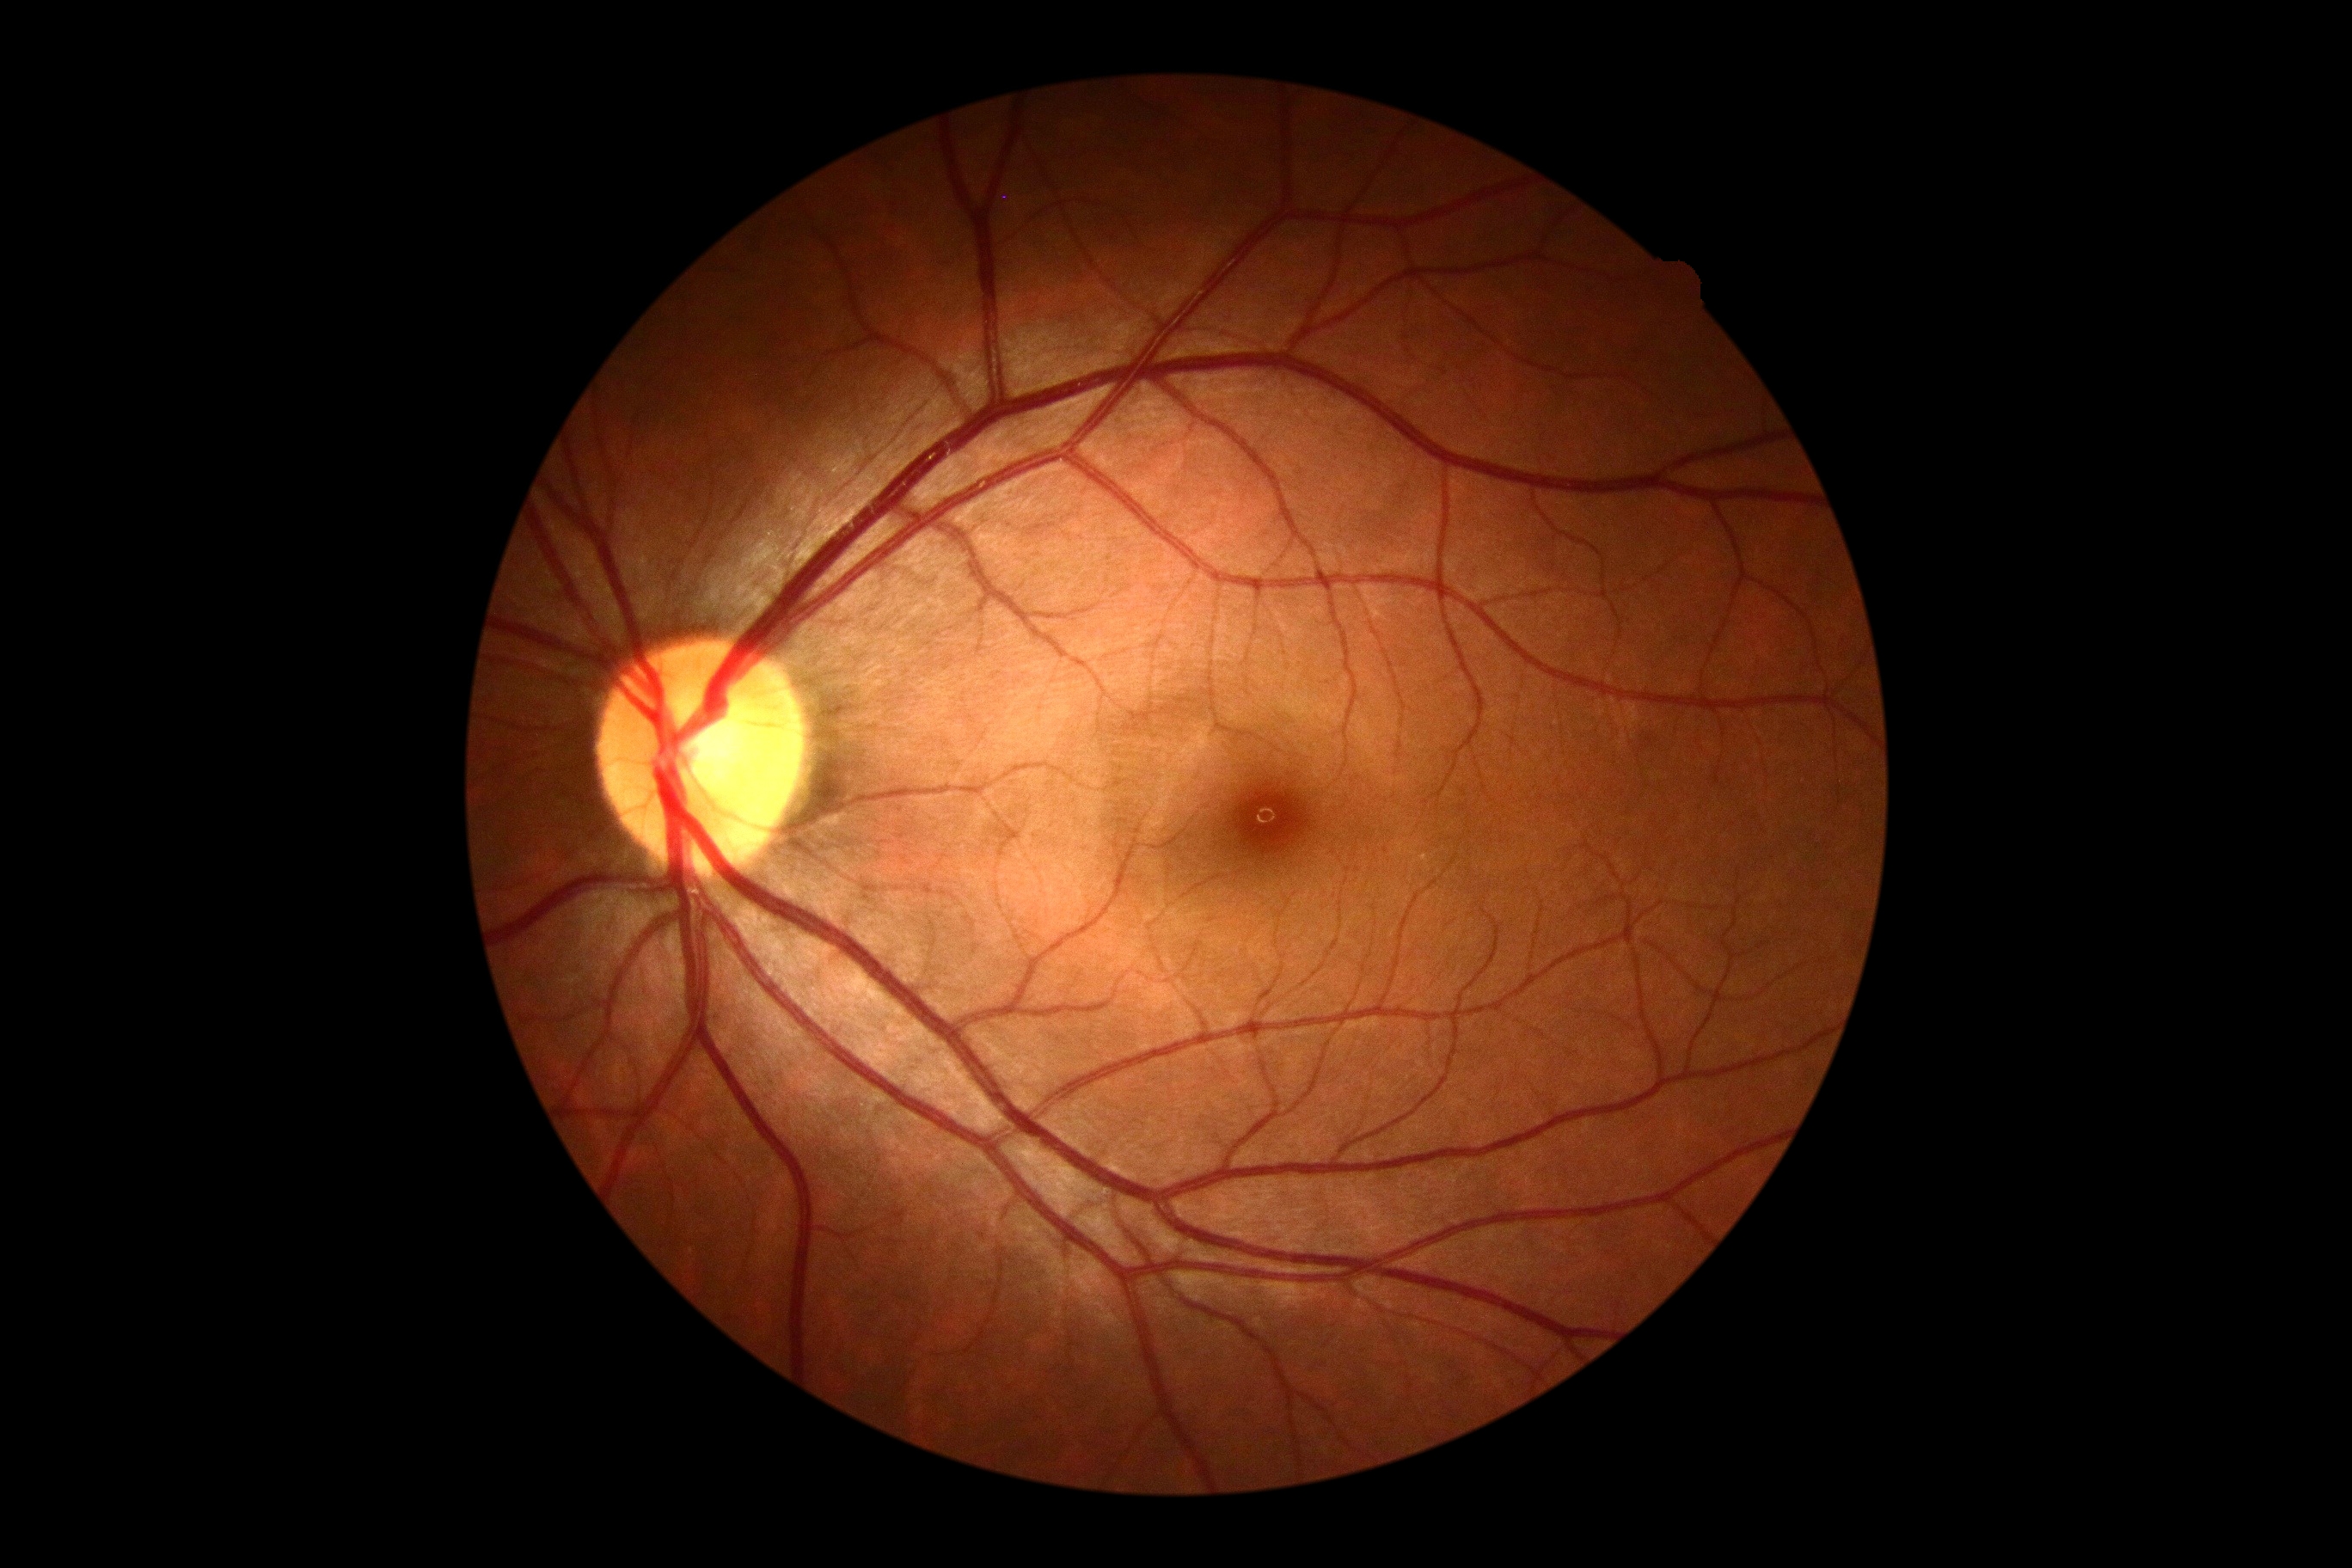

retinopathy@0/4.